NIDEK AFC-230; Davis DR grading; 848 x 848 pixels; nonmydriatic fundus photograph; FOV: 45 degrees.
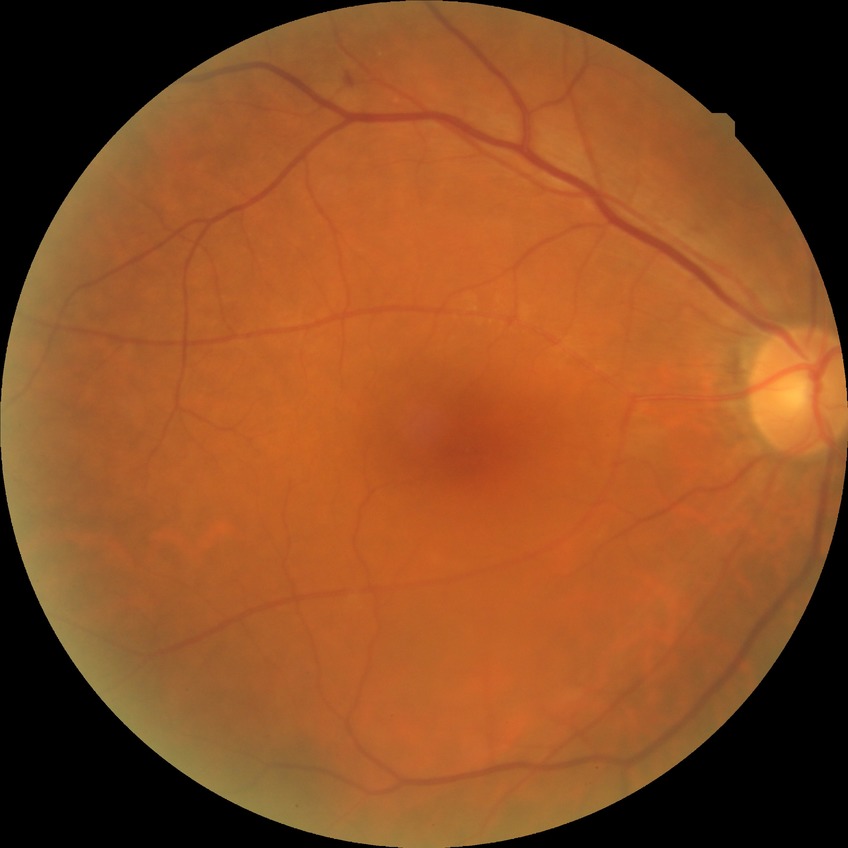 Diabetic retinopathy (DR) is SDR (simple diabetic retinopathy).